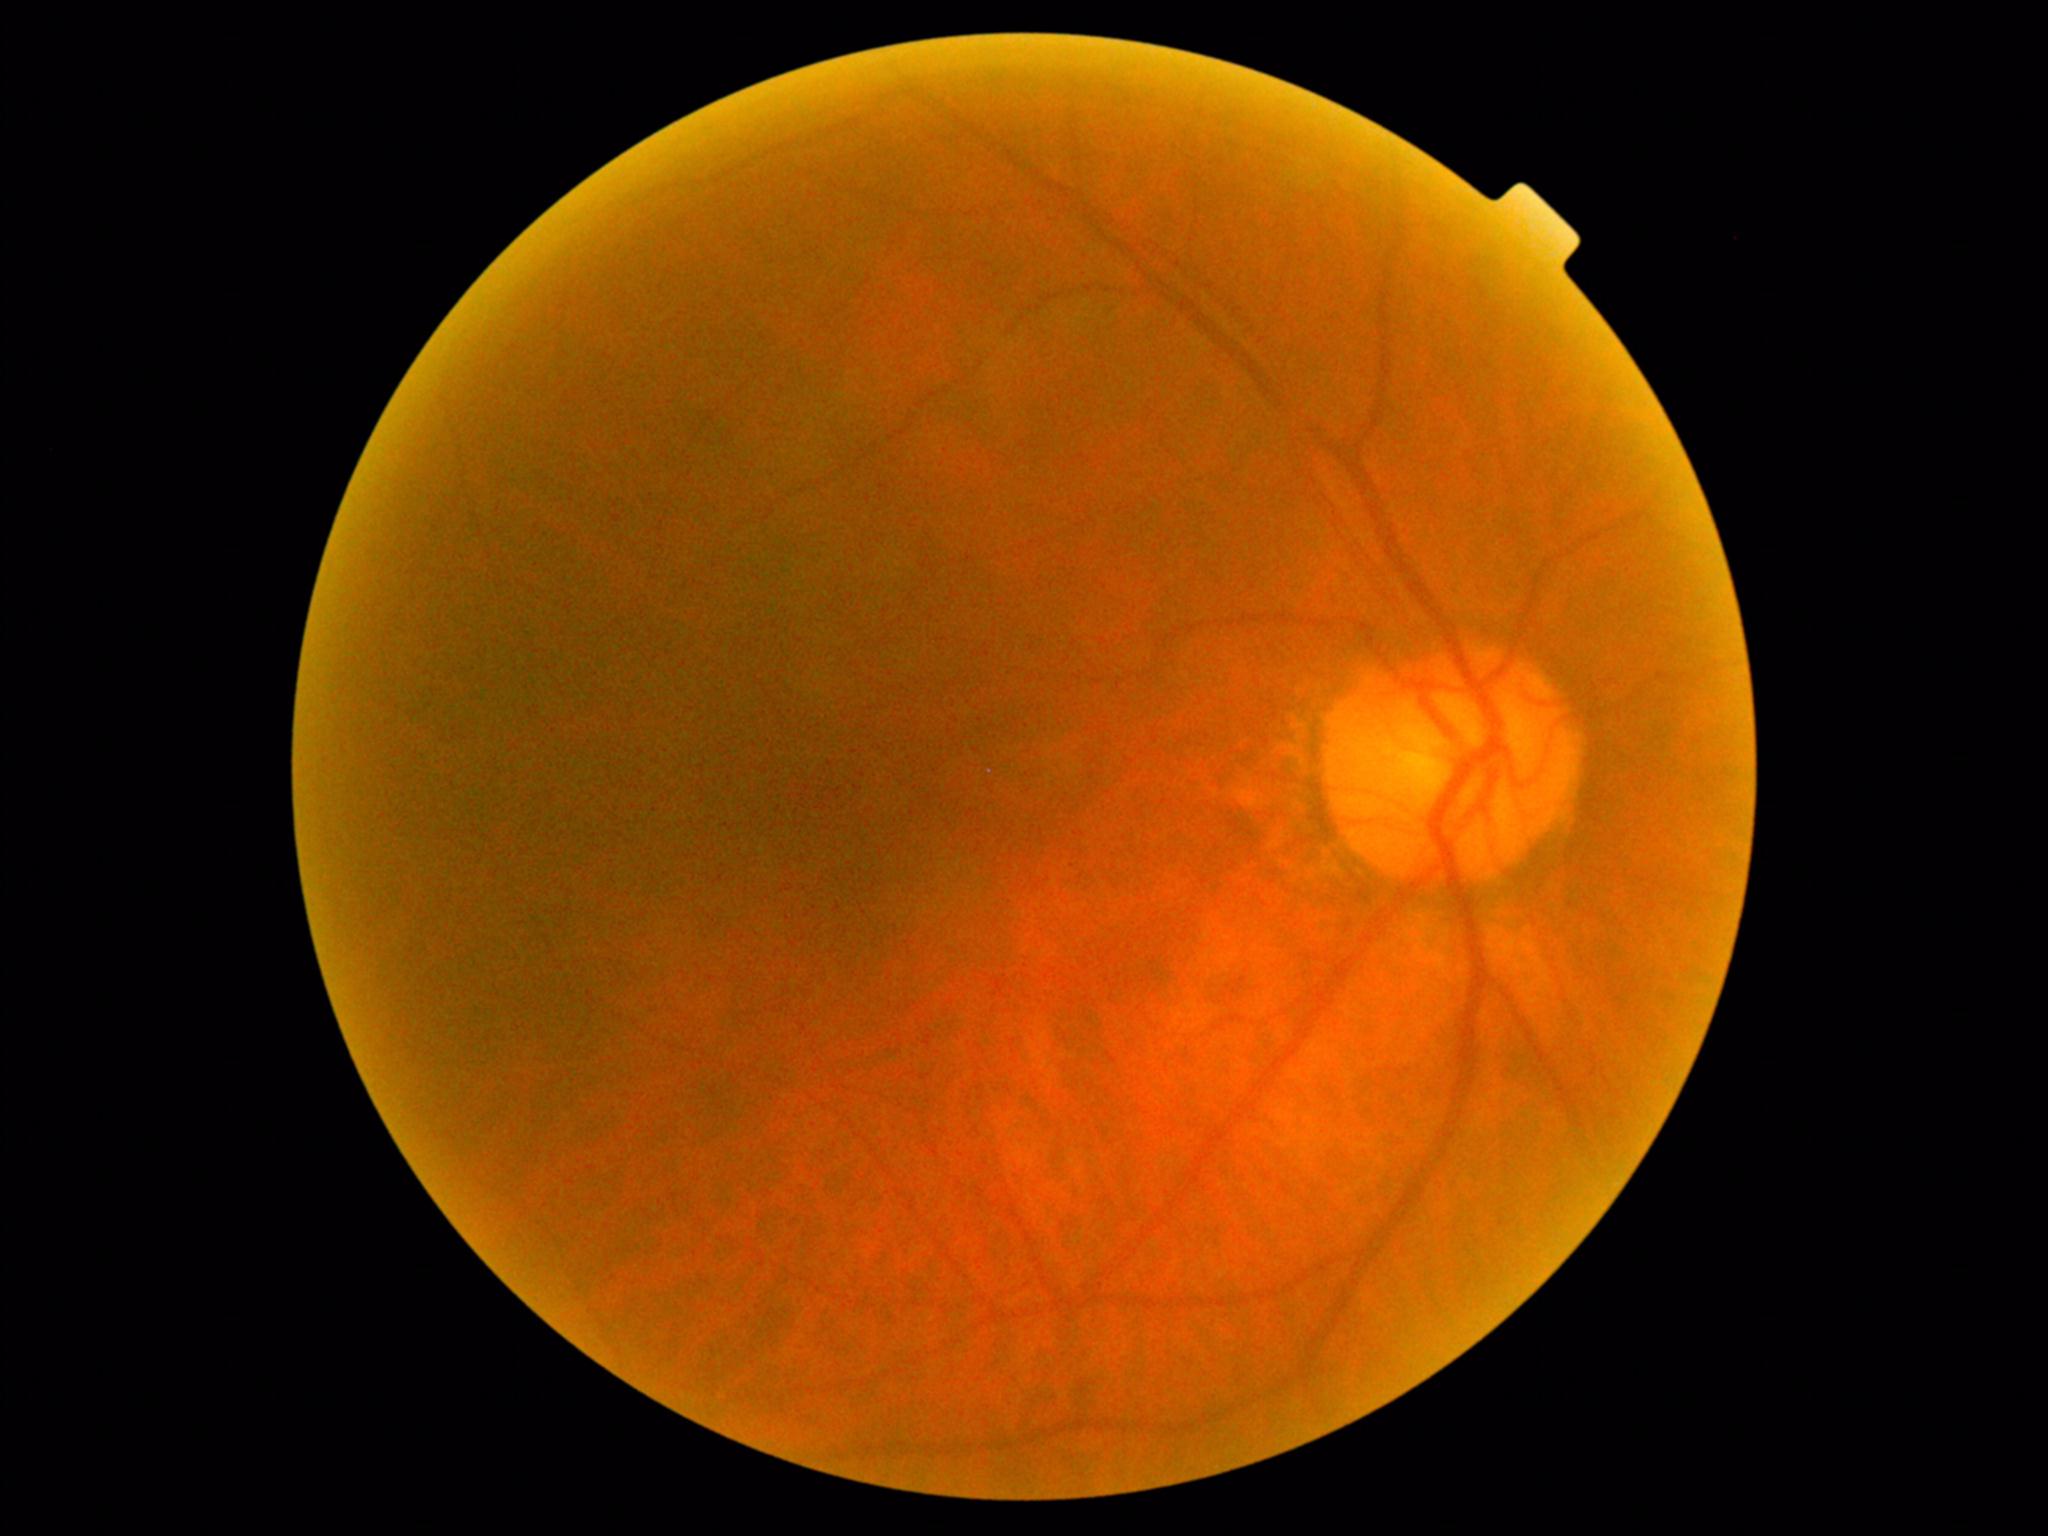 No diabetic retinal disease findings.
DR is 0/4.